Image size 2048x1536. 45° field of view
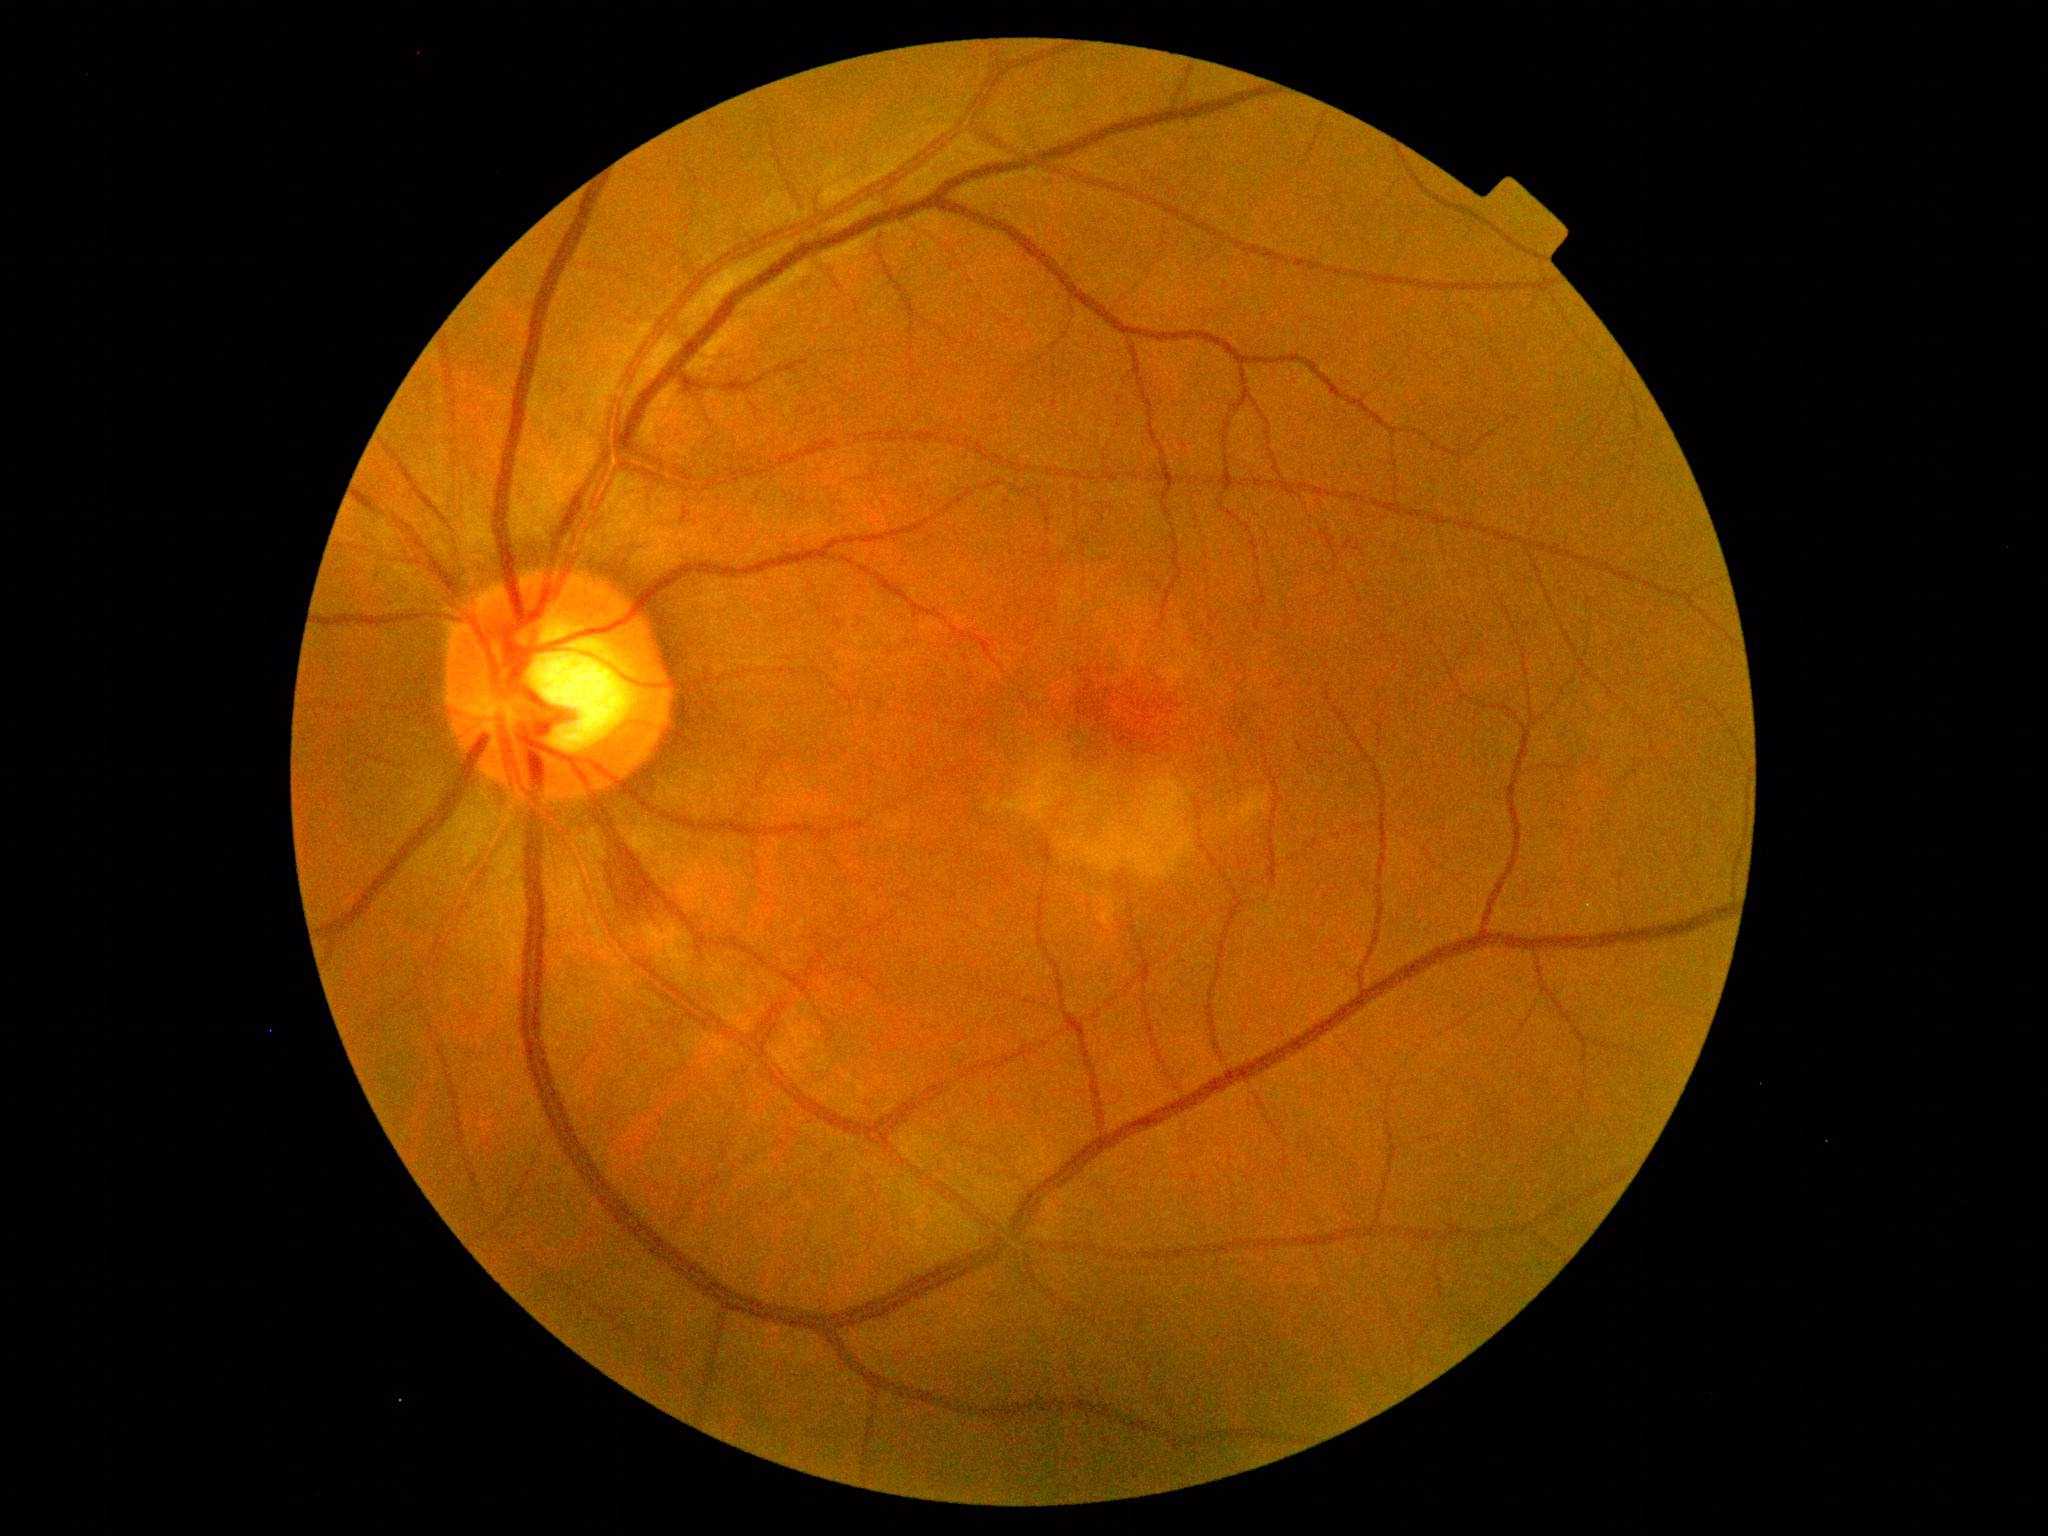

Retinopathy is 2.